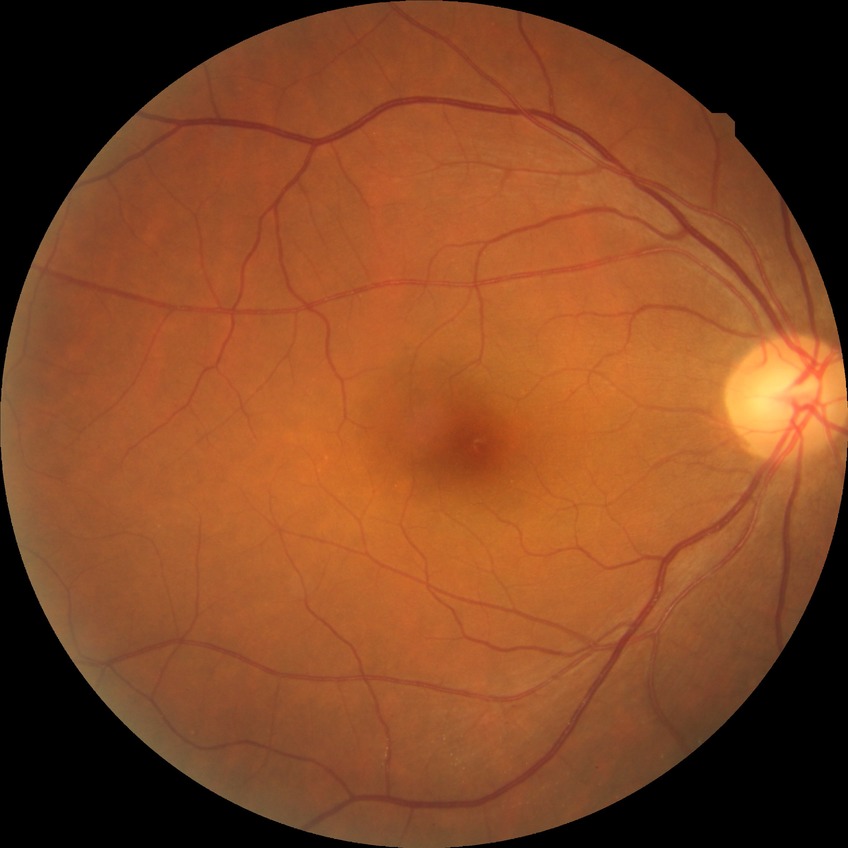

  davis_grade: NDR